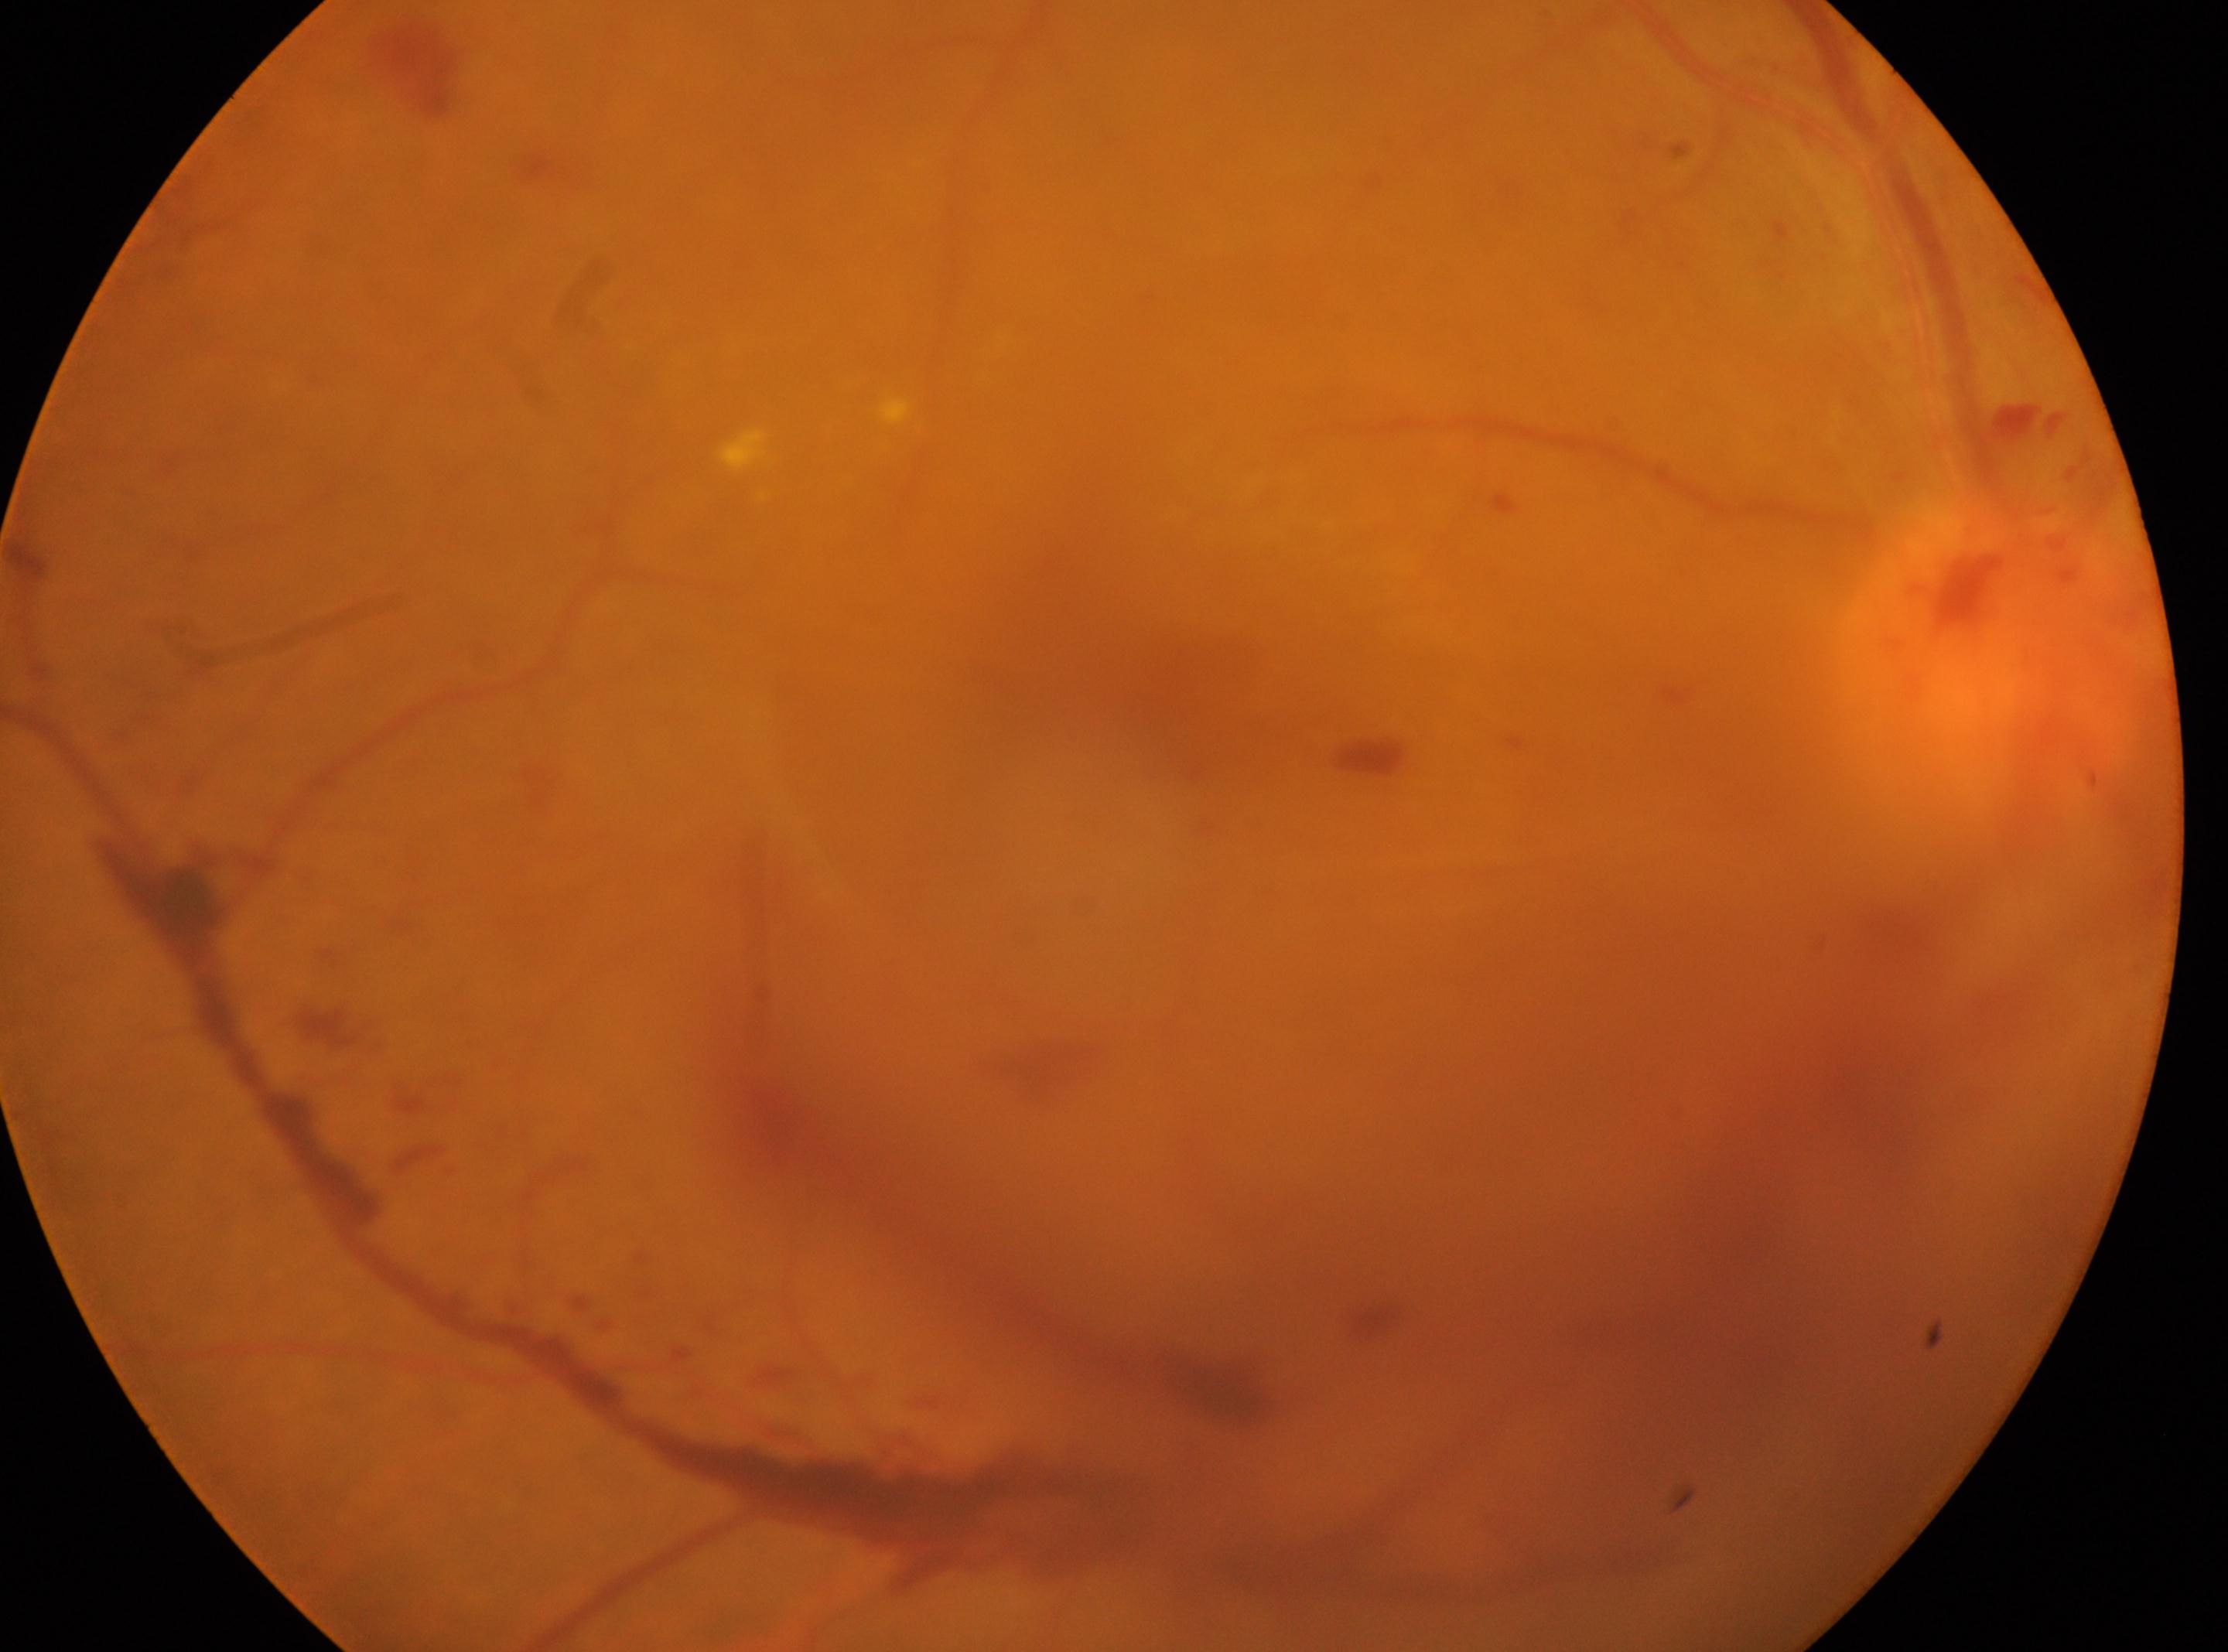 DR class: proliferative diabetic retinopathy; eye: OD; diabetic retinopathy (DR): grade 4; ONH: 1976, 664; macular center: 1184, 698.